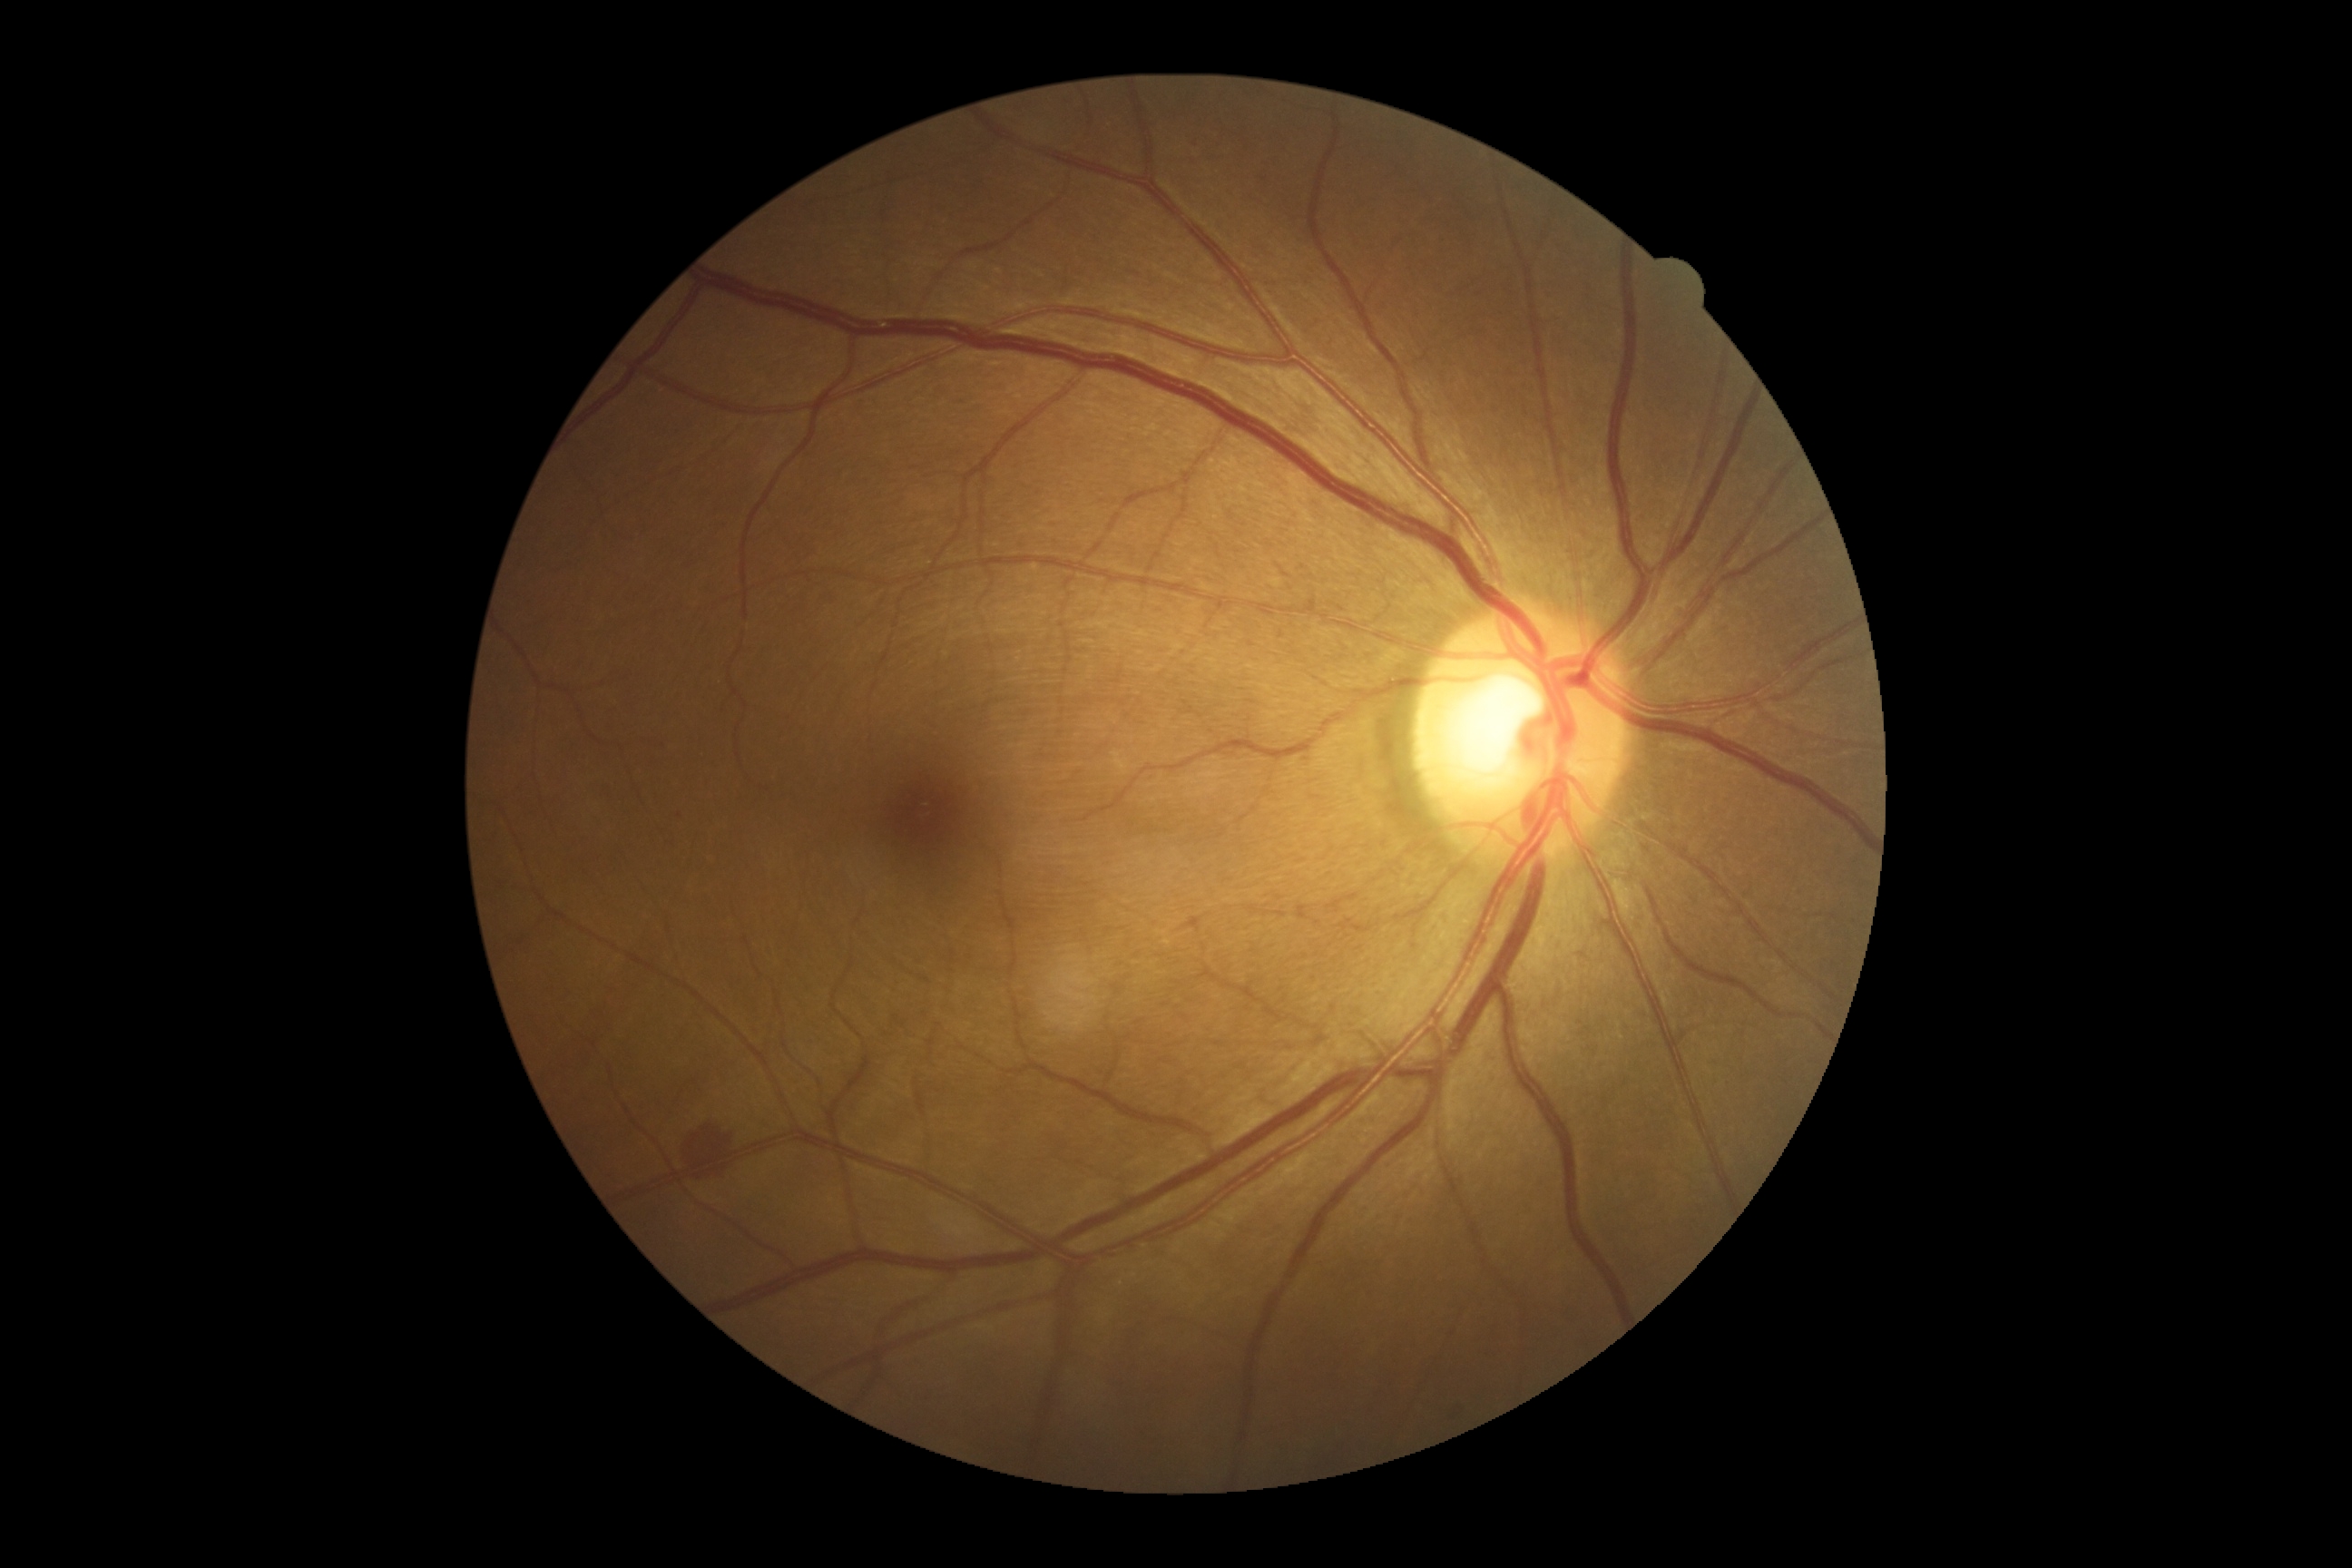 DR severity=grade 2 (moderate NPDR).